Fundus photo; 1504 x 1000 pixels
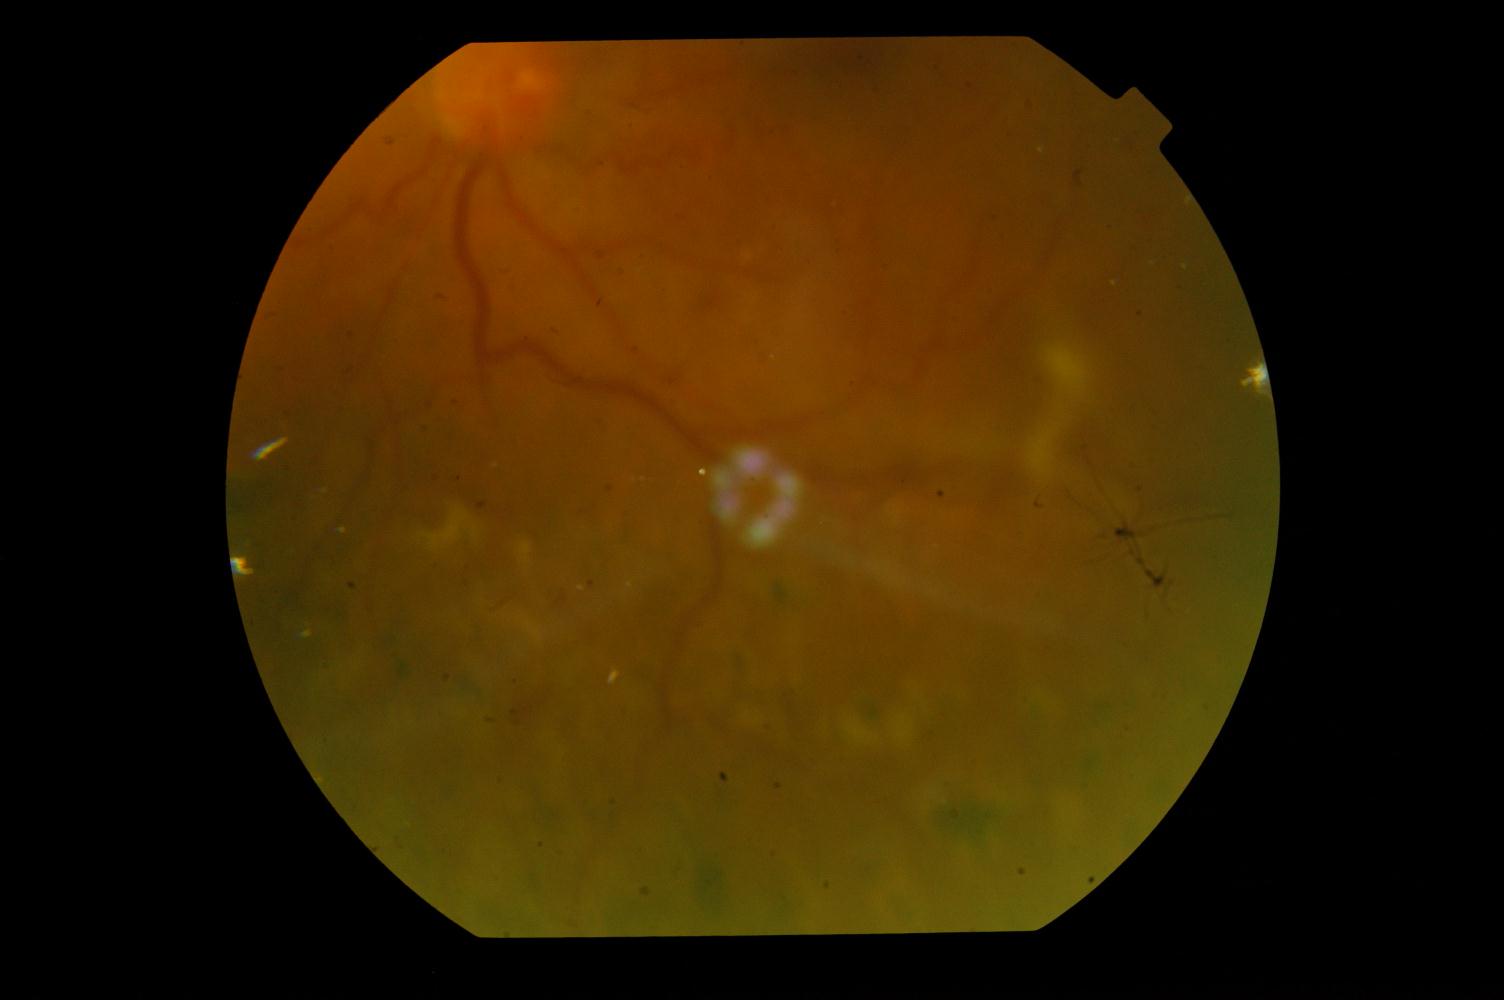 Findings: diabetic retinopathy.